Davis DR grading.
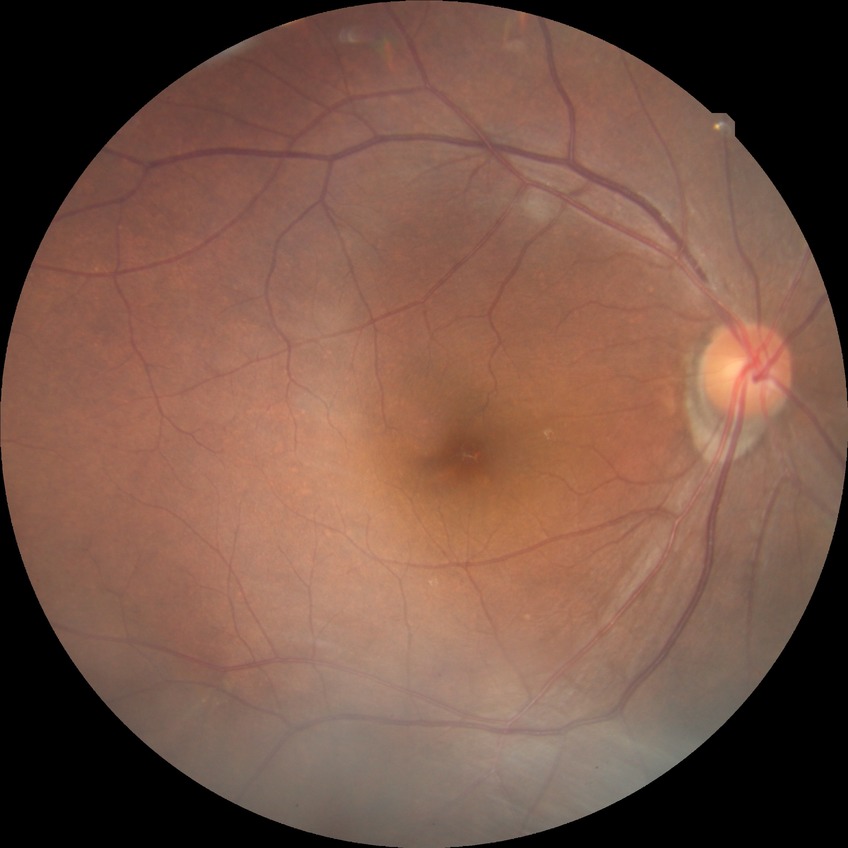
Diabetic retinopathy (DR): NDR (no diabetic retinopathy).